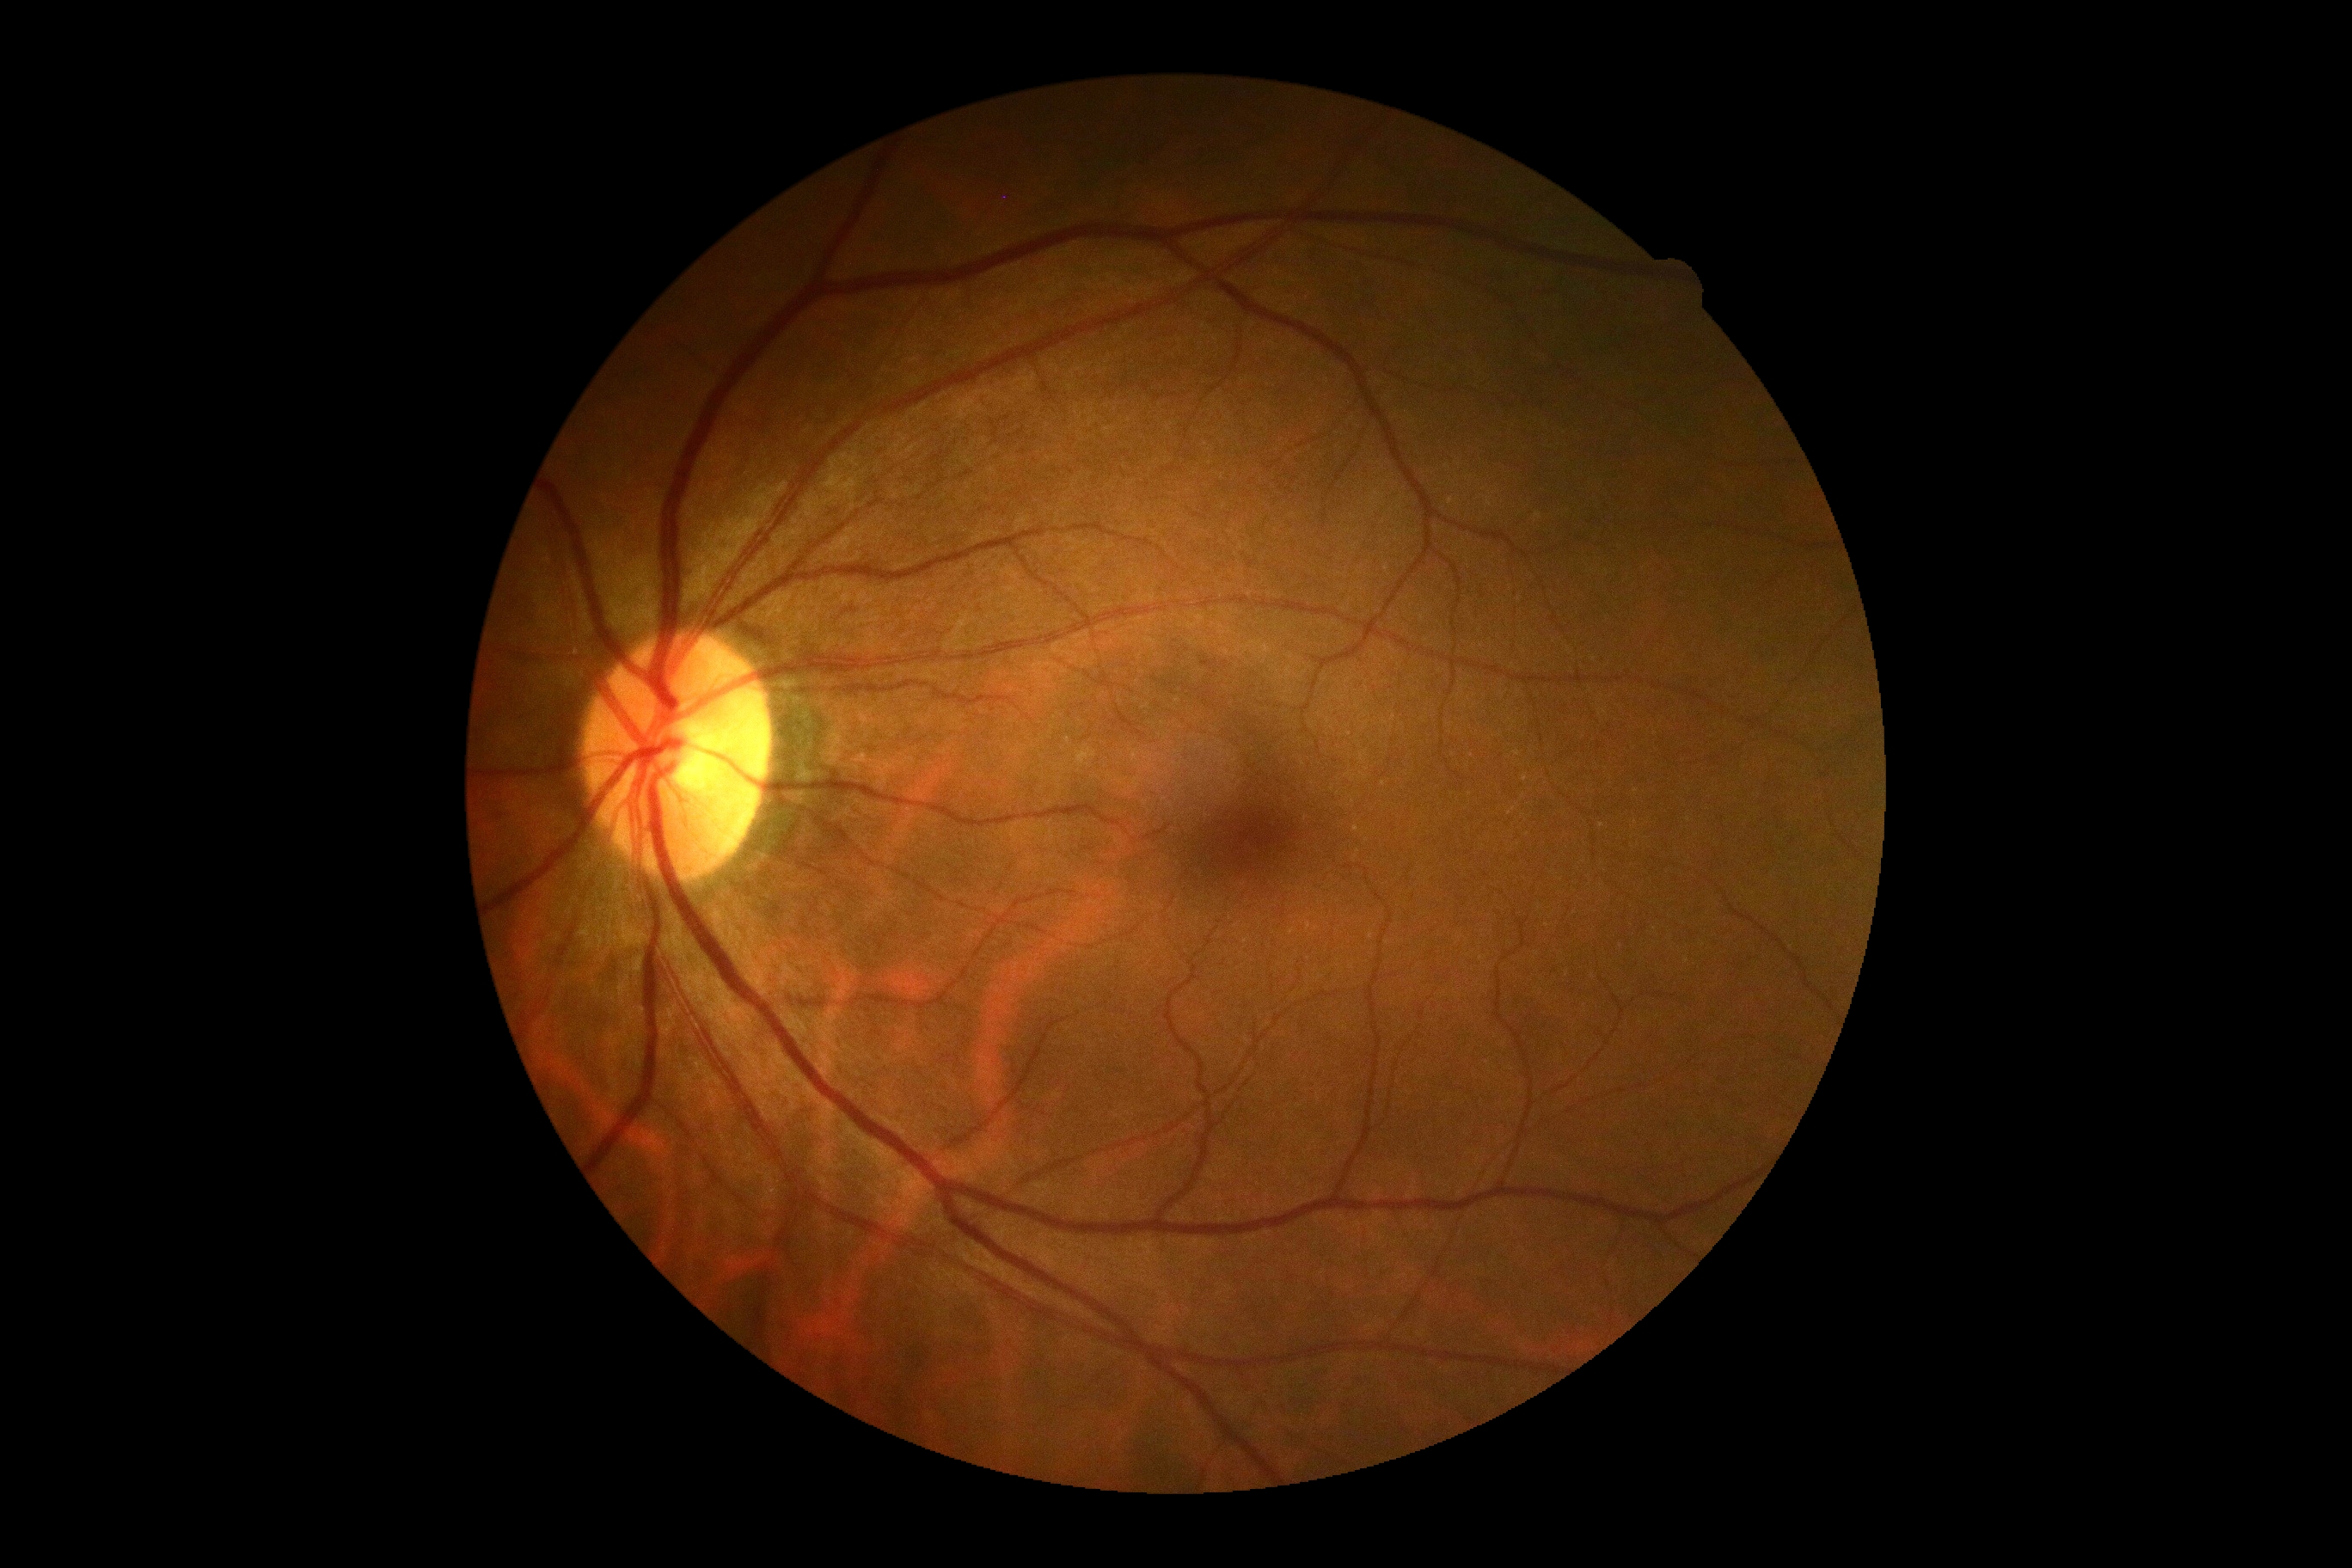 {"dr_grade": "grade 0"}